Macula at the center of the field, captured on a Kowa VX-10α fundus camera, fundus photo — 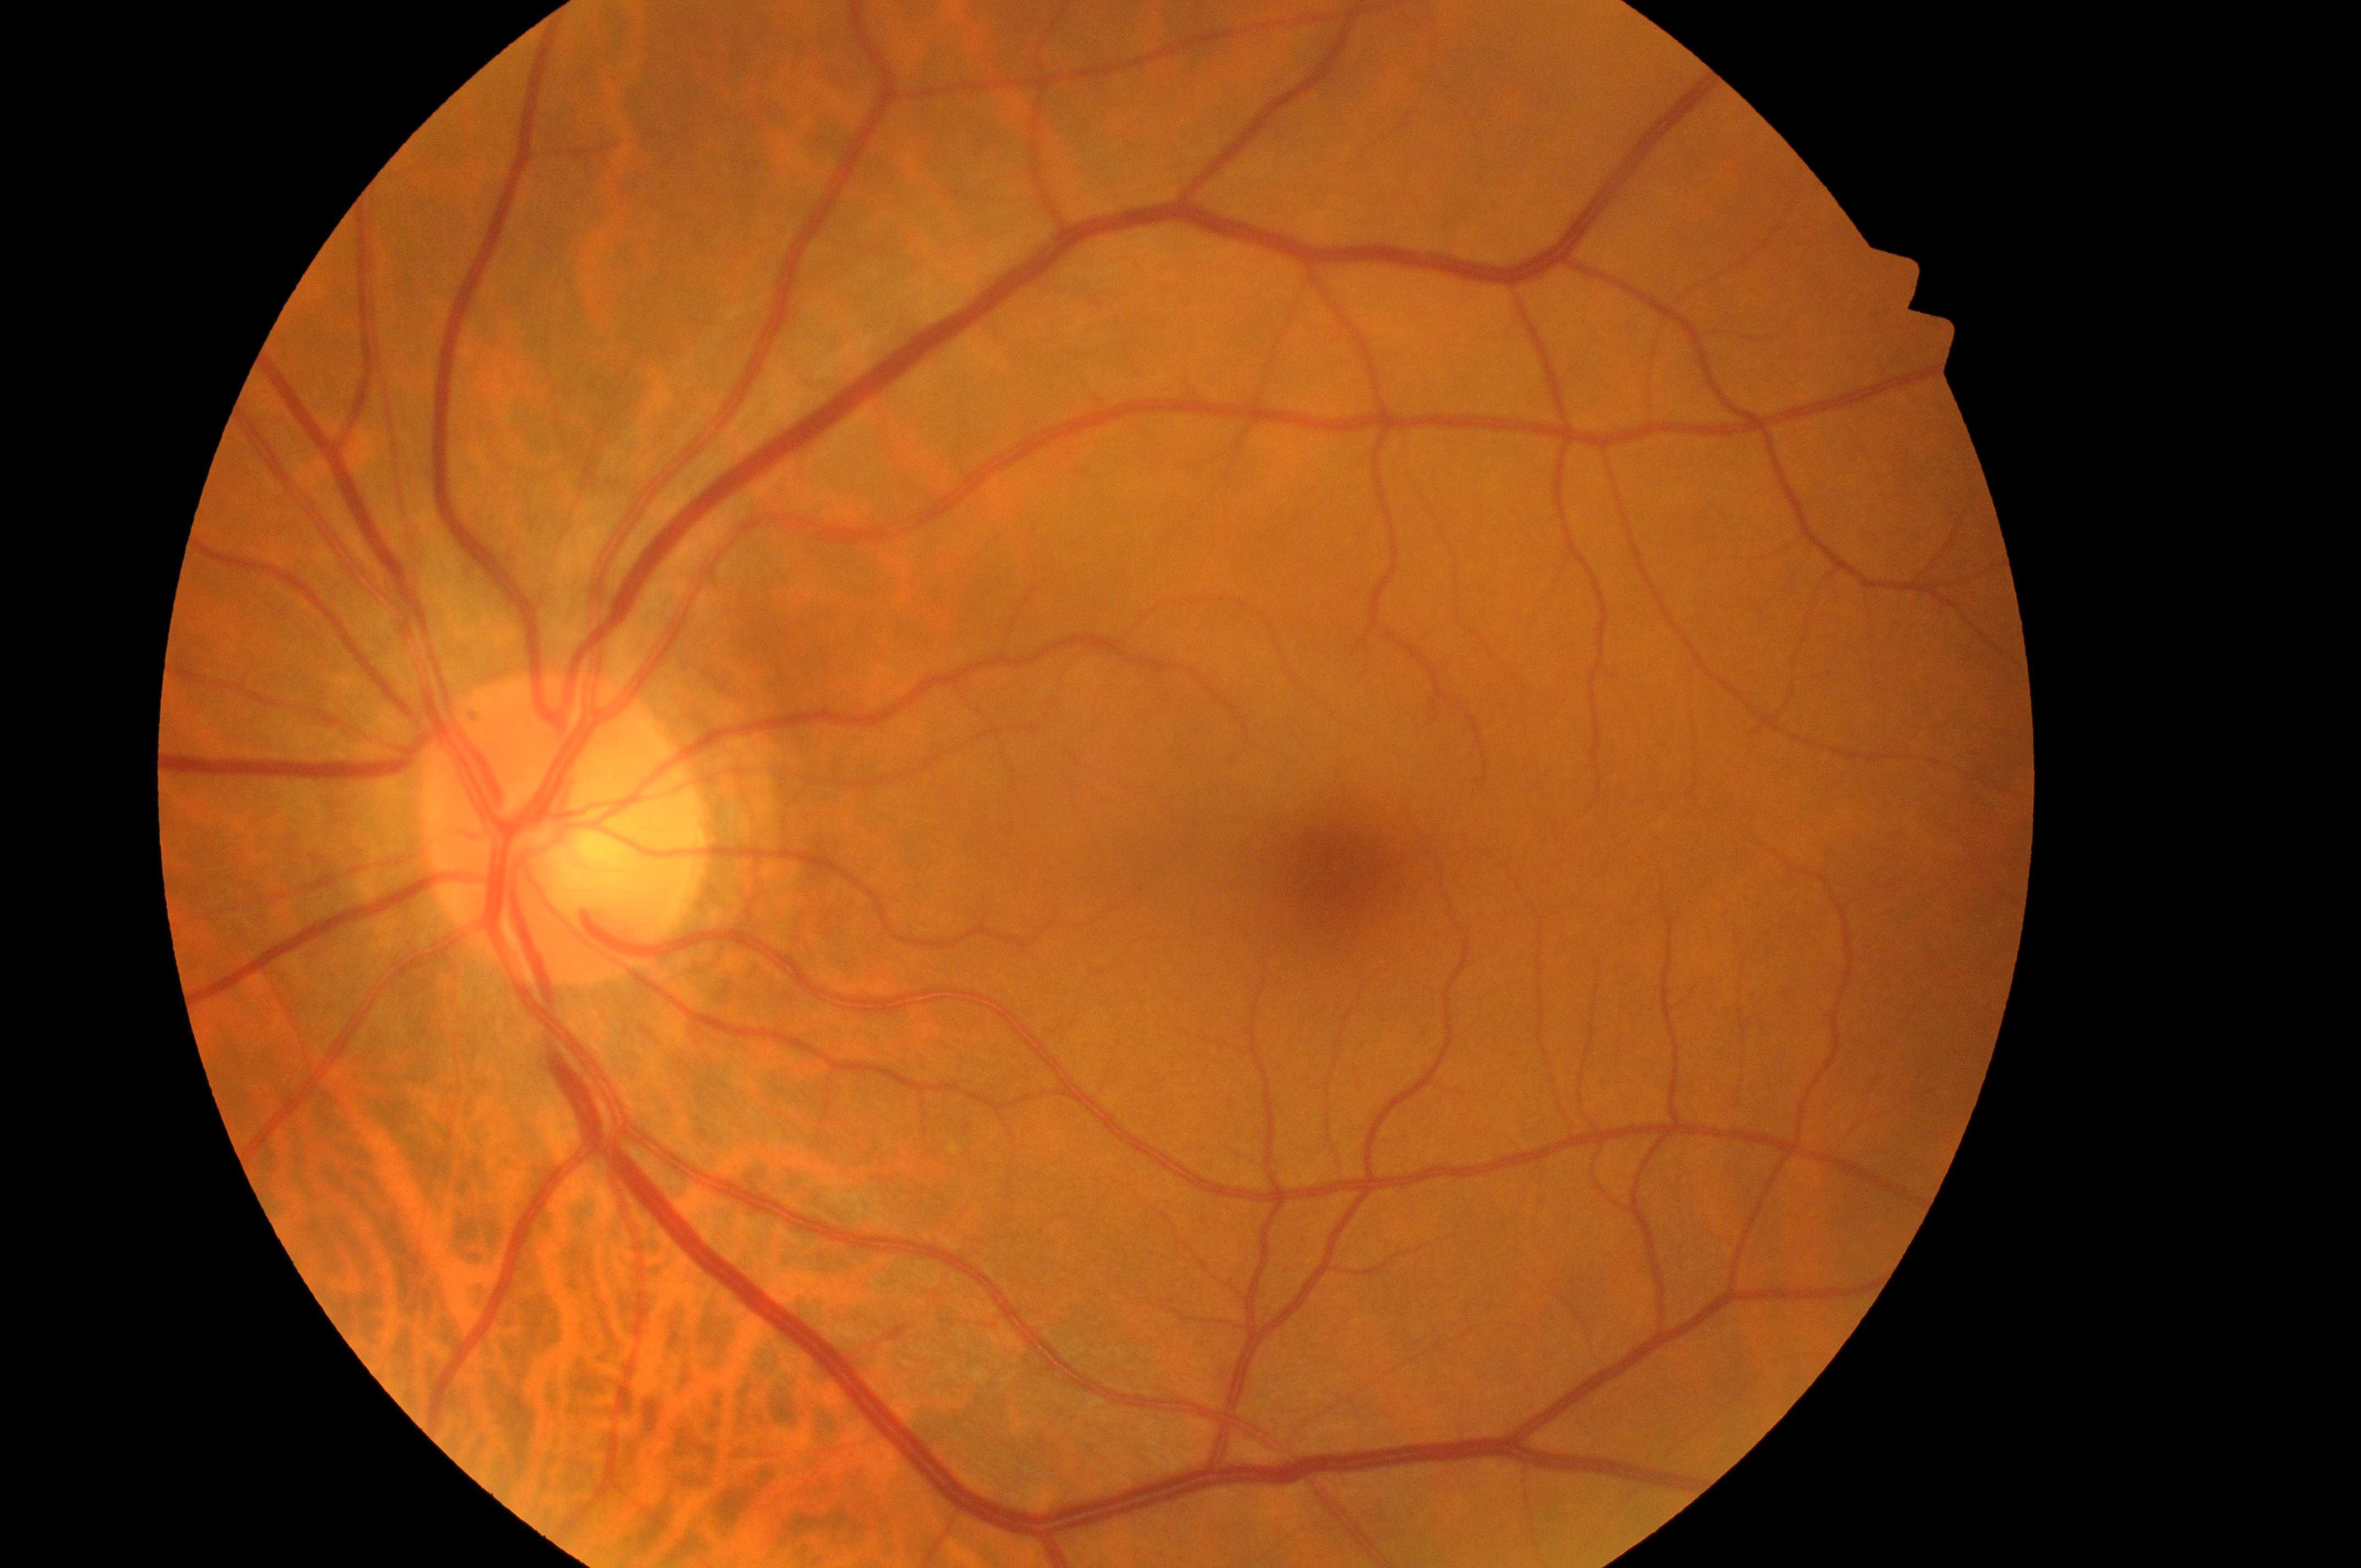
Optic disc: 554px, 845px. DME risk is 0. The image shows the OS. DR grade is 0. The foveal center is at 1349px, 872px.